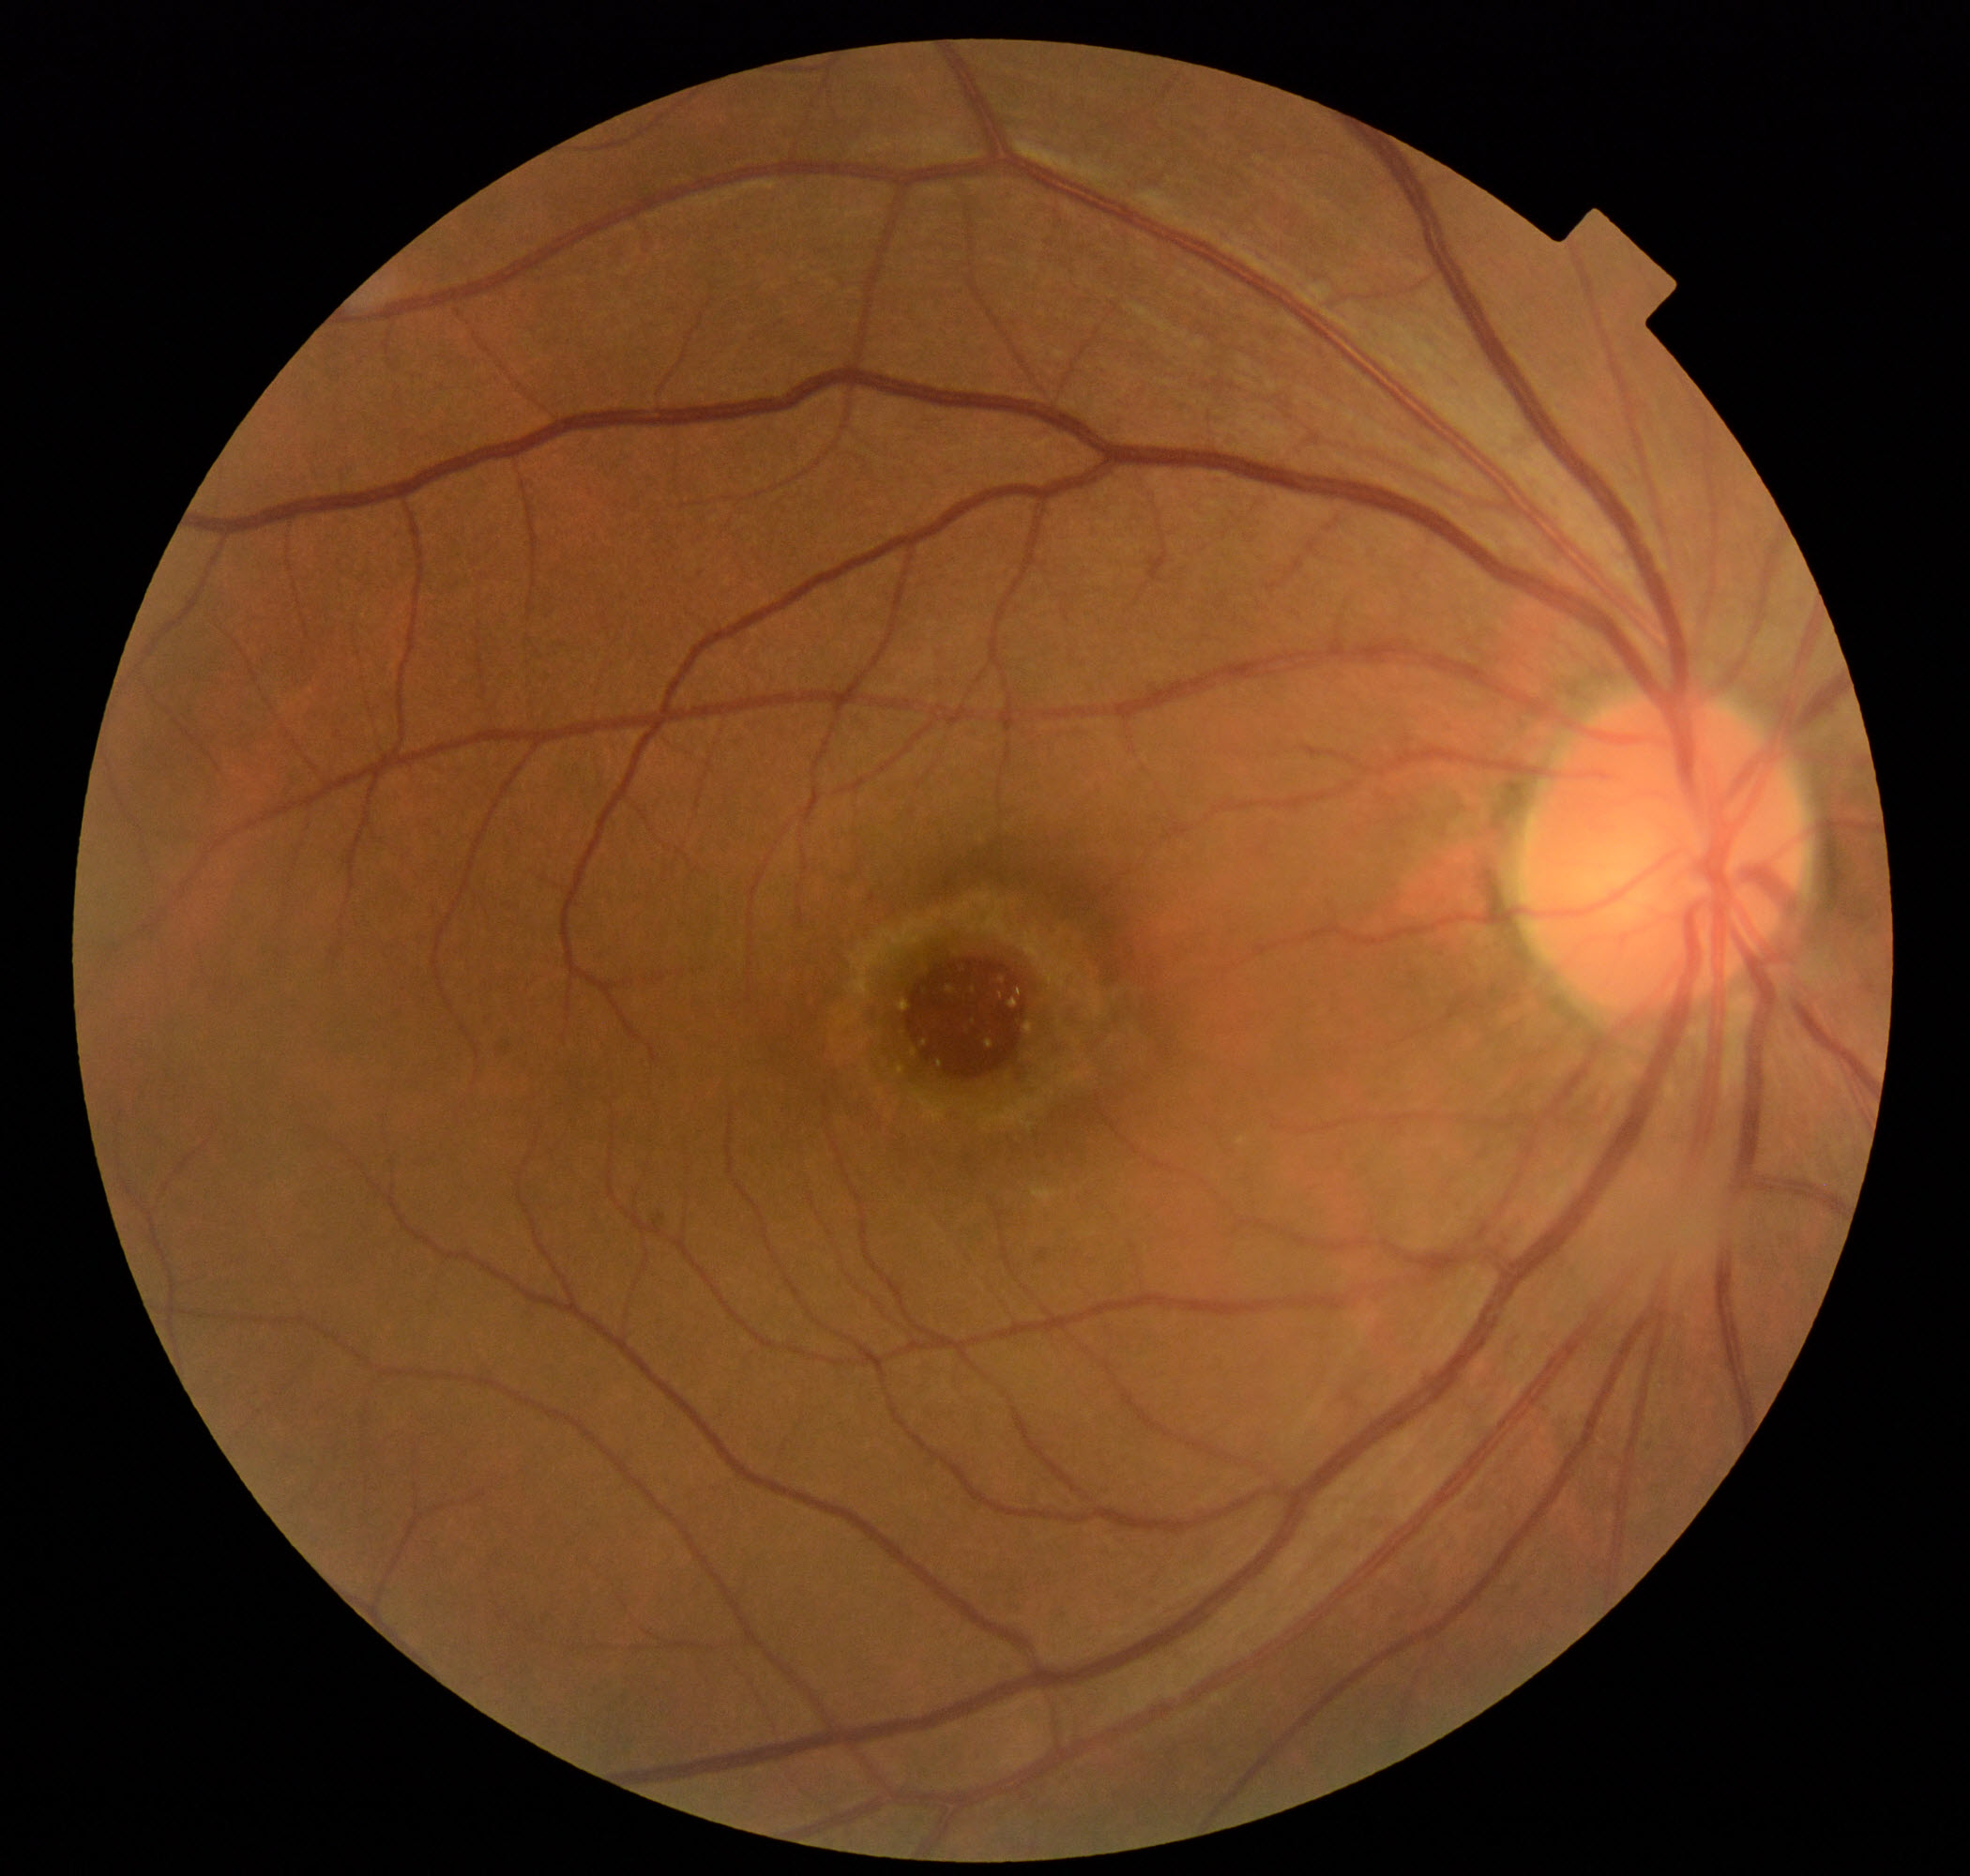

Fundus appearance consistent with macular hole.